Posterior pole color fundus photograph:
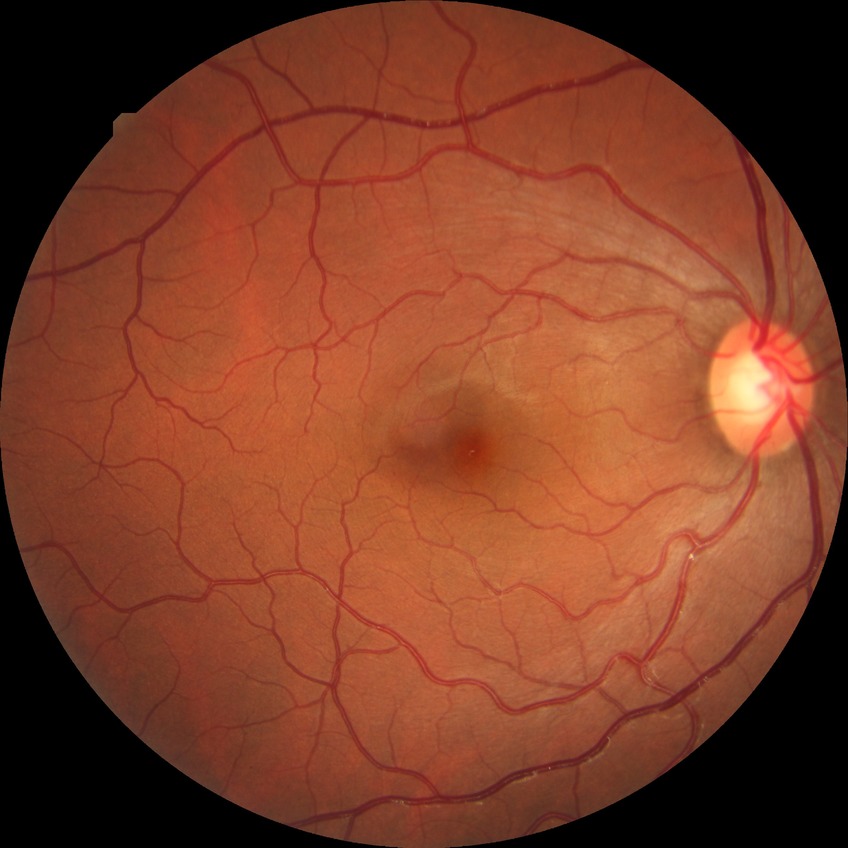

davis_grade: NDR (no diabetic retinopathy)